1923 by 1932 pixels; fundus photo; 45° field of view: 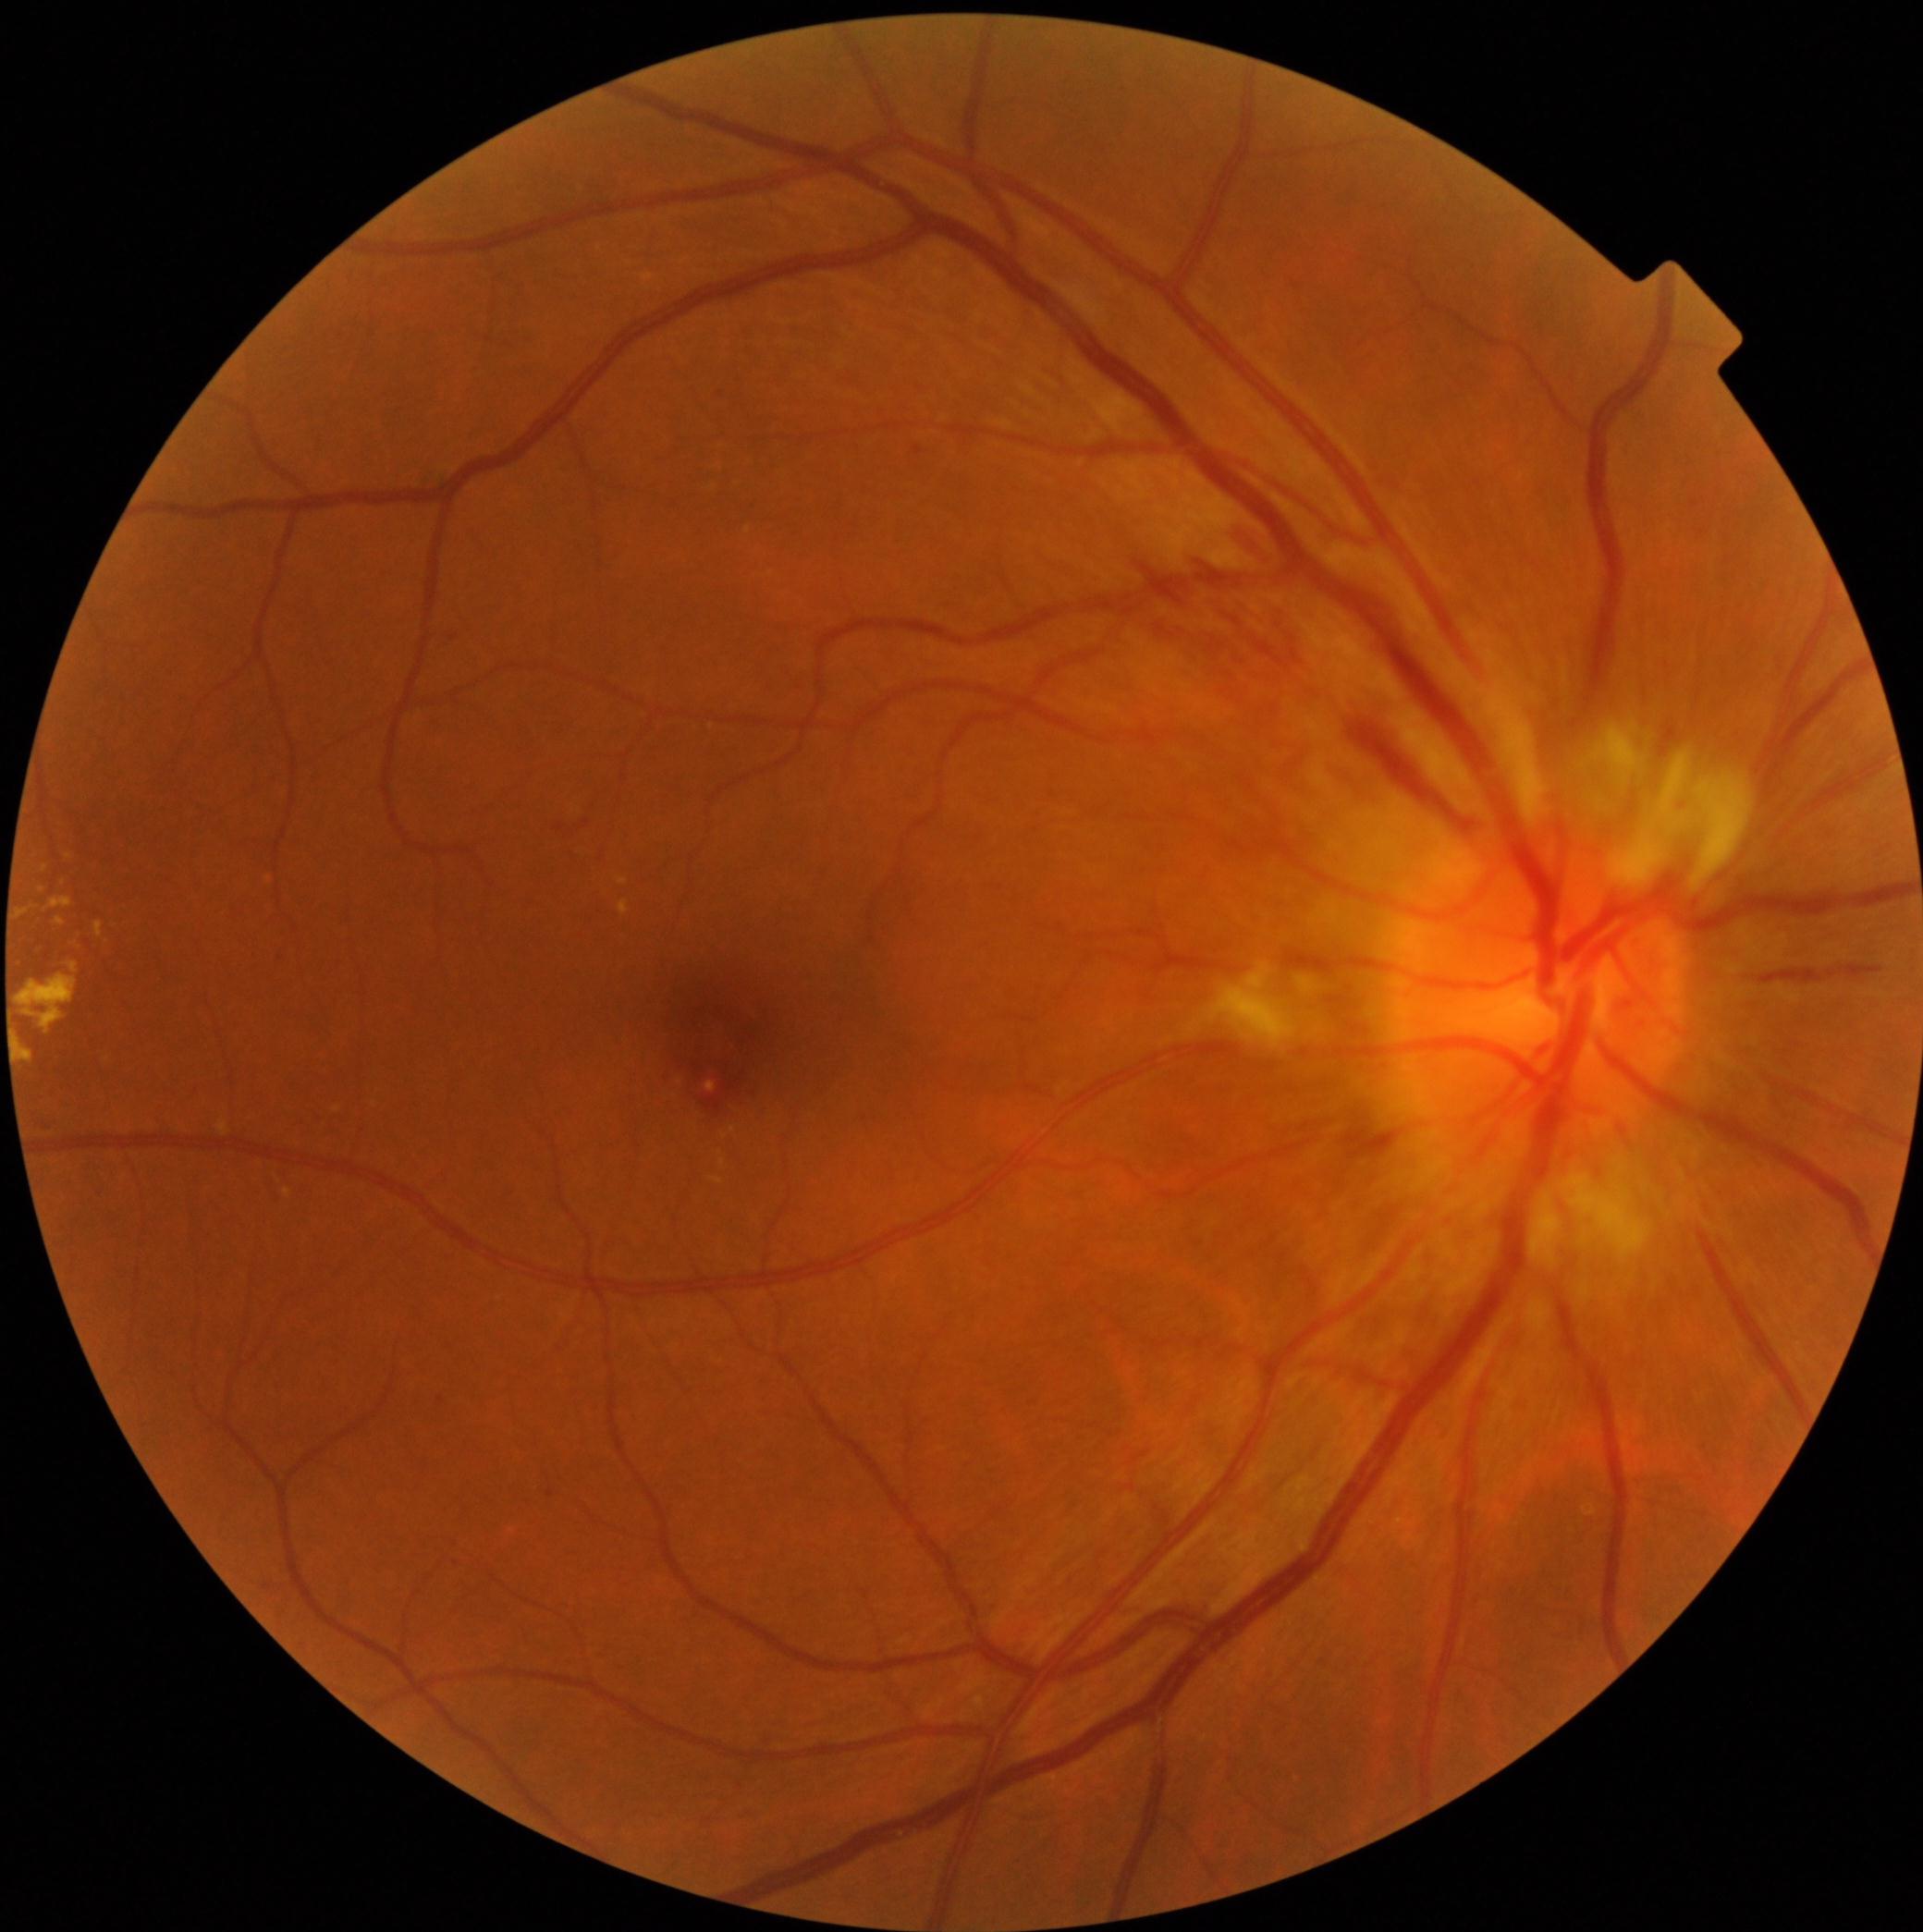
Retinopathy: grade 2
Lesions identified (partial list):
hard exudates (subset): BBox(16, 907, 34, 920); BBox(707, 1082, 717, 1093); BBox(619, 879, 628, 887); BBox(14, 974, 78, 1036); BBox(44, 898, 74, 912); BBox(284, 1190, 293, 1199); BBox(94, 922, 104, 939); BBox(68, 963, 80, 974); BBox(55, 918, 67, 927); BBox(619, 901, 628, 916); BBox(16, 1040, 34, 1064)
Smaller hard exudates around [42,891]; [69,857]; [45,870]
hemorrhages (subset): BBox(1341, 710, 1475, 828); BBox(1173, 596, 1184, 611); BBox(1212, 602, 1289, 664); BBox(1263, 600, 1308, 649); BBox(1759, 963, 1884, 984); BBox(1141, 562, 1160, 585); BBox(1228, 523, 1276, 558); BBox(1151, 618, 1177, 640); BBox(695, 1070, 733, 1113)
microaneurysms: BBox(547, 1491, 555, 1498); BBox(46, 1122, 54, 1130); BBox(913, 446, 922, 456)
Smaller microaneurysms around [442,1400]; [722,394]; [278,959]; [454,639]
soft exudates: BBox(1581, 728, 1756, 892); BBox(1186, 961, 1347, 1055); BBox(1535, 1146, 1679, 1306)